Infant wide-field retinal image
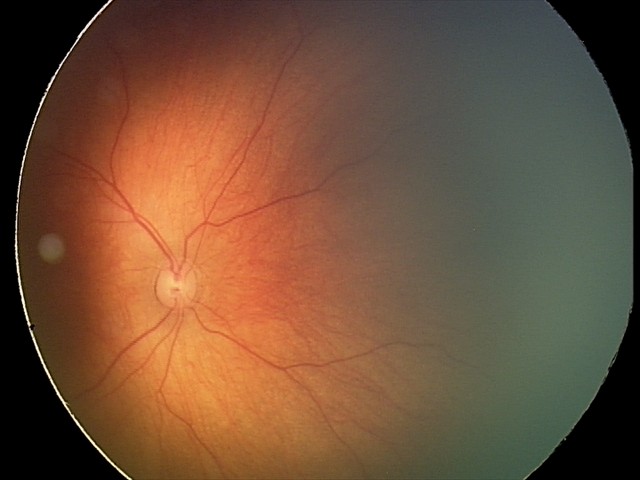

Assessment: normal